2048 x 1536 pixels · color fundus photograph · FOV: 45 degrees.
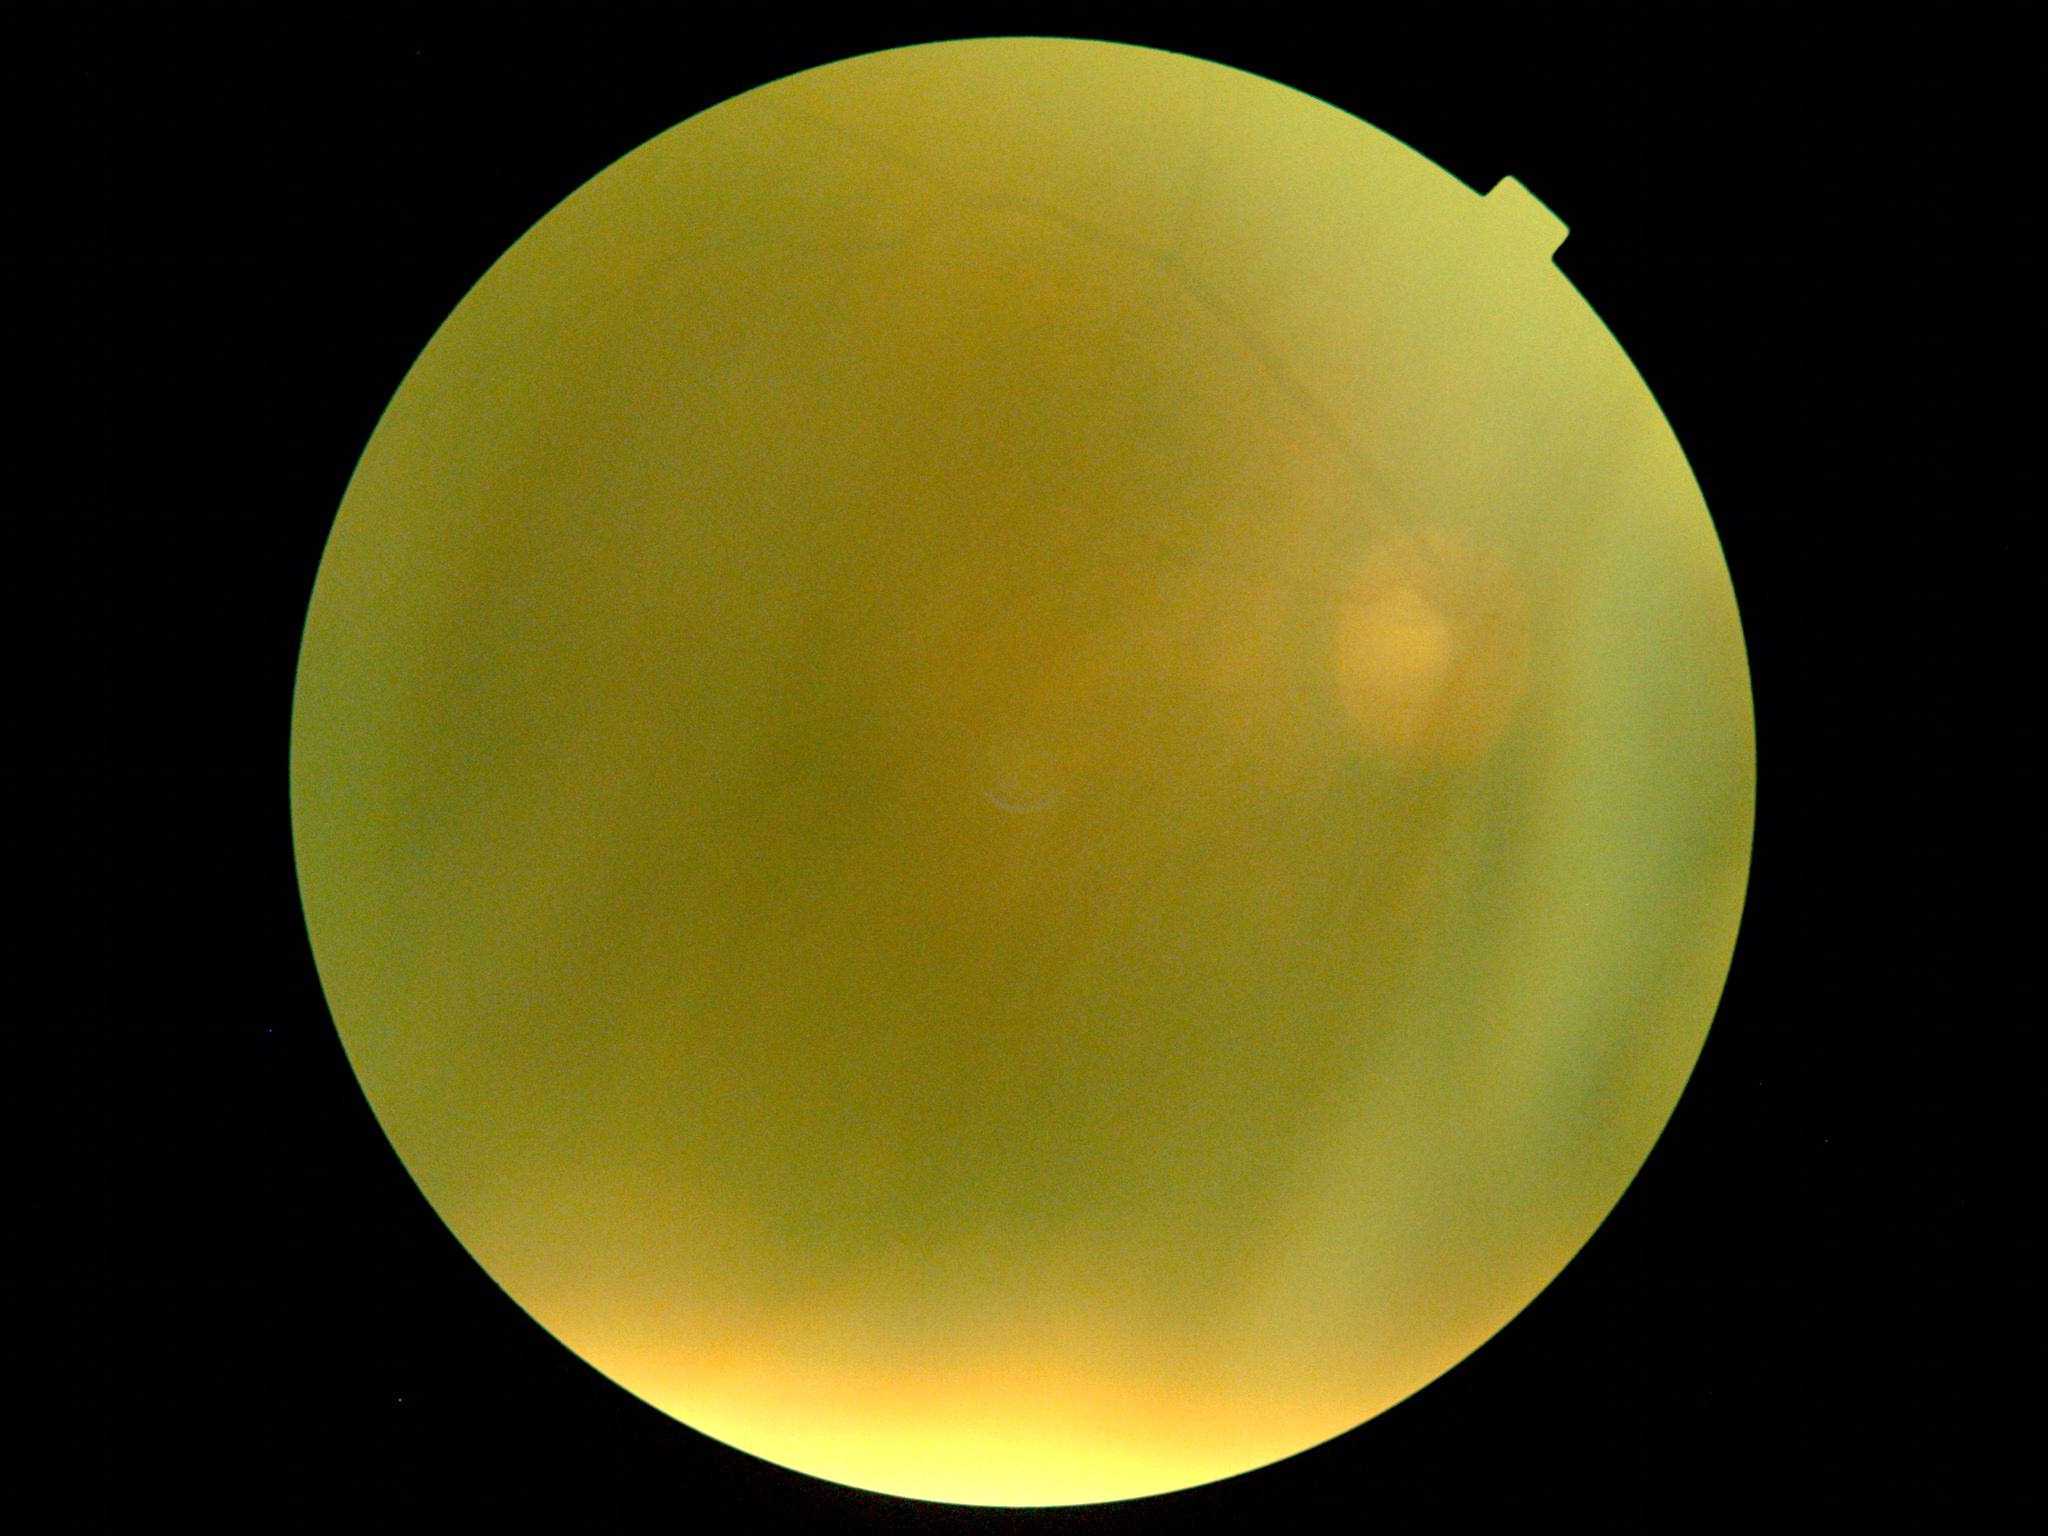

image quality: insufficient
diabetic retinopathy grade: ungradable due to poor image quality